35° field of view before cropping; optic disc region of a color fundus photo: 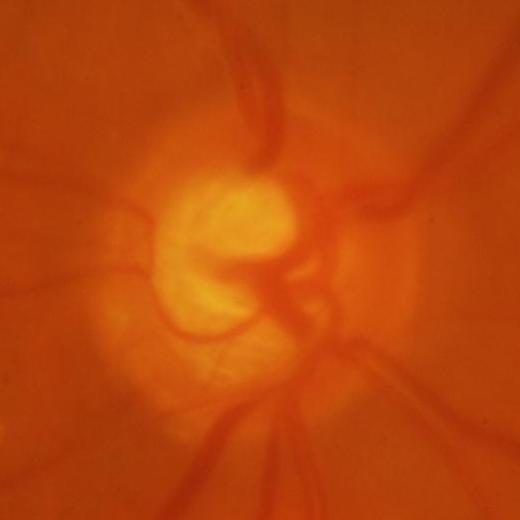

Impression = glaucomatous changes.